Wide-field fundus photograph from neonatal ROP screening. Camera: Clarity RetCam 3 (130° FOV). 640x480px:
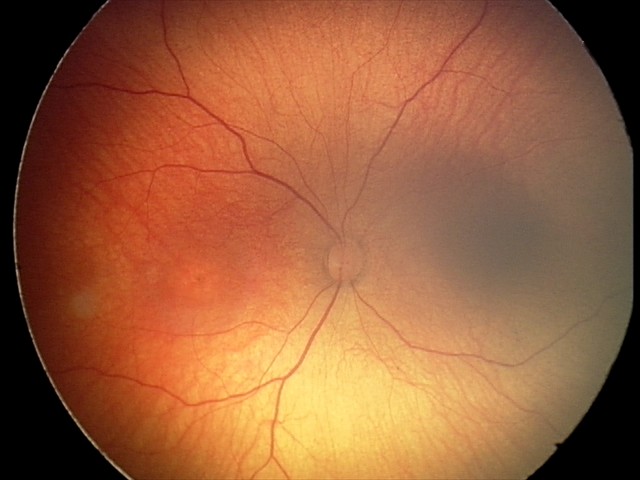
Impression: no abnormal retinal findings.